2352 by 1568 pixels — 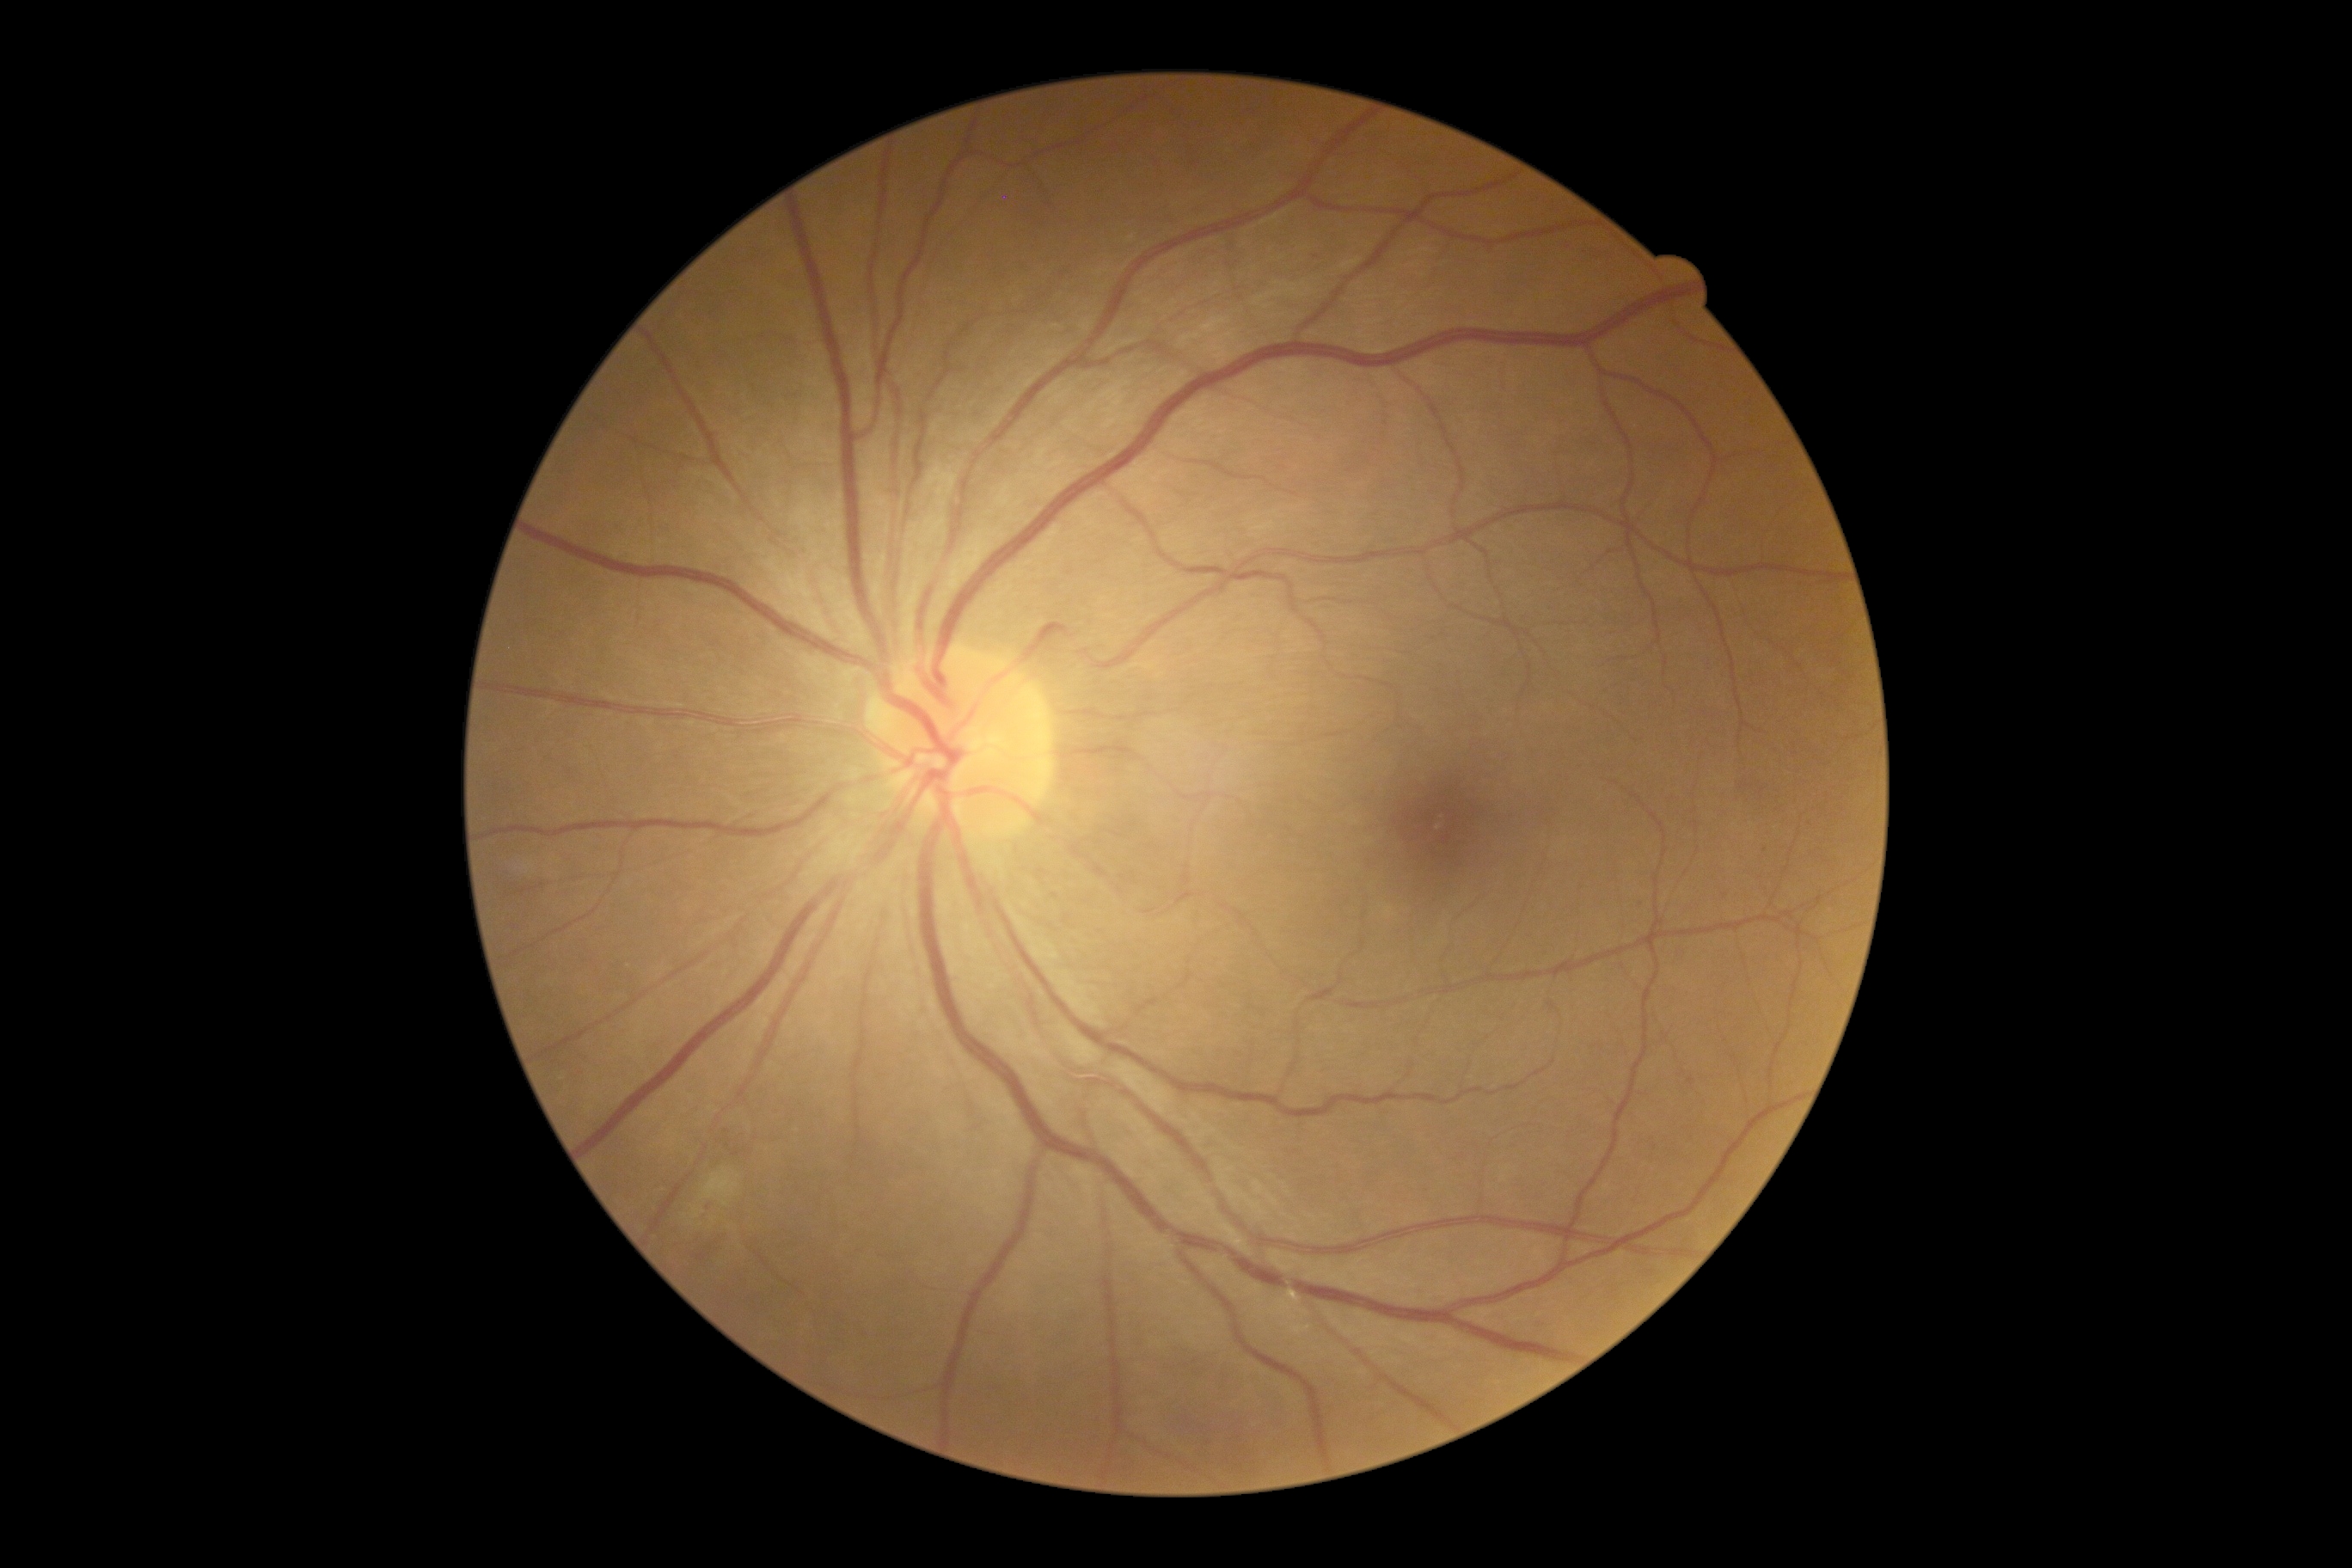
DR severity=moderate NPDR (grade 2); DR class=non-proliferative diabetic retinopathy.